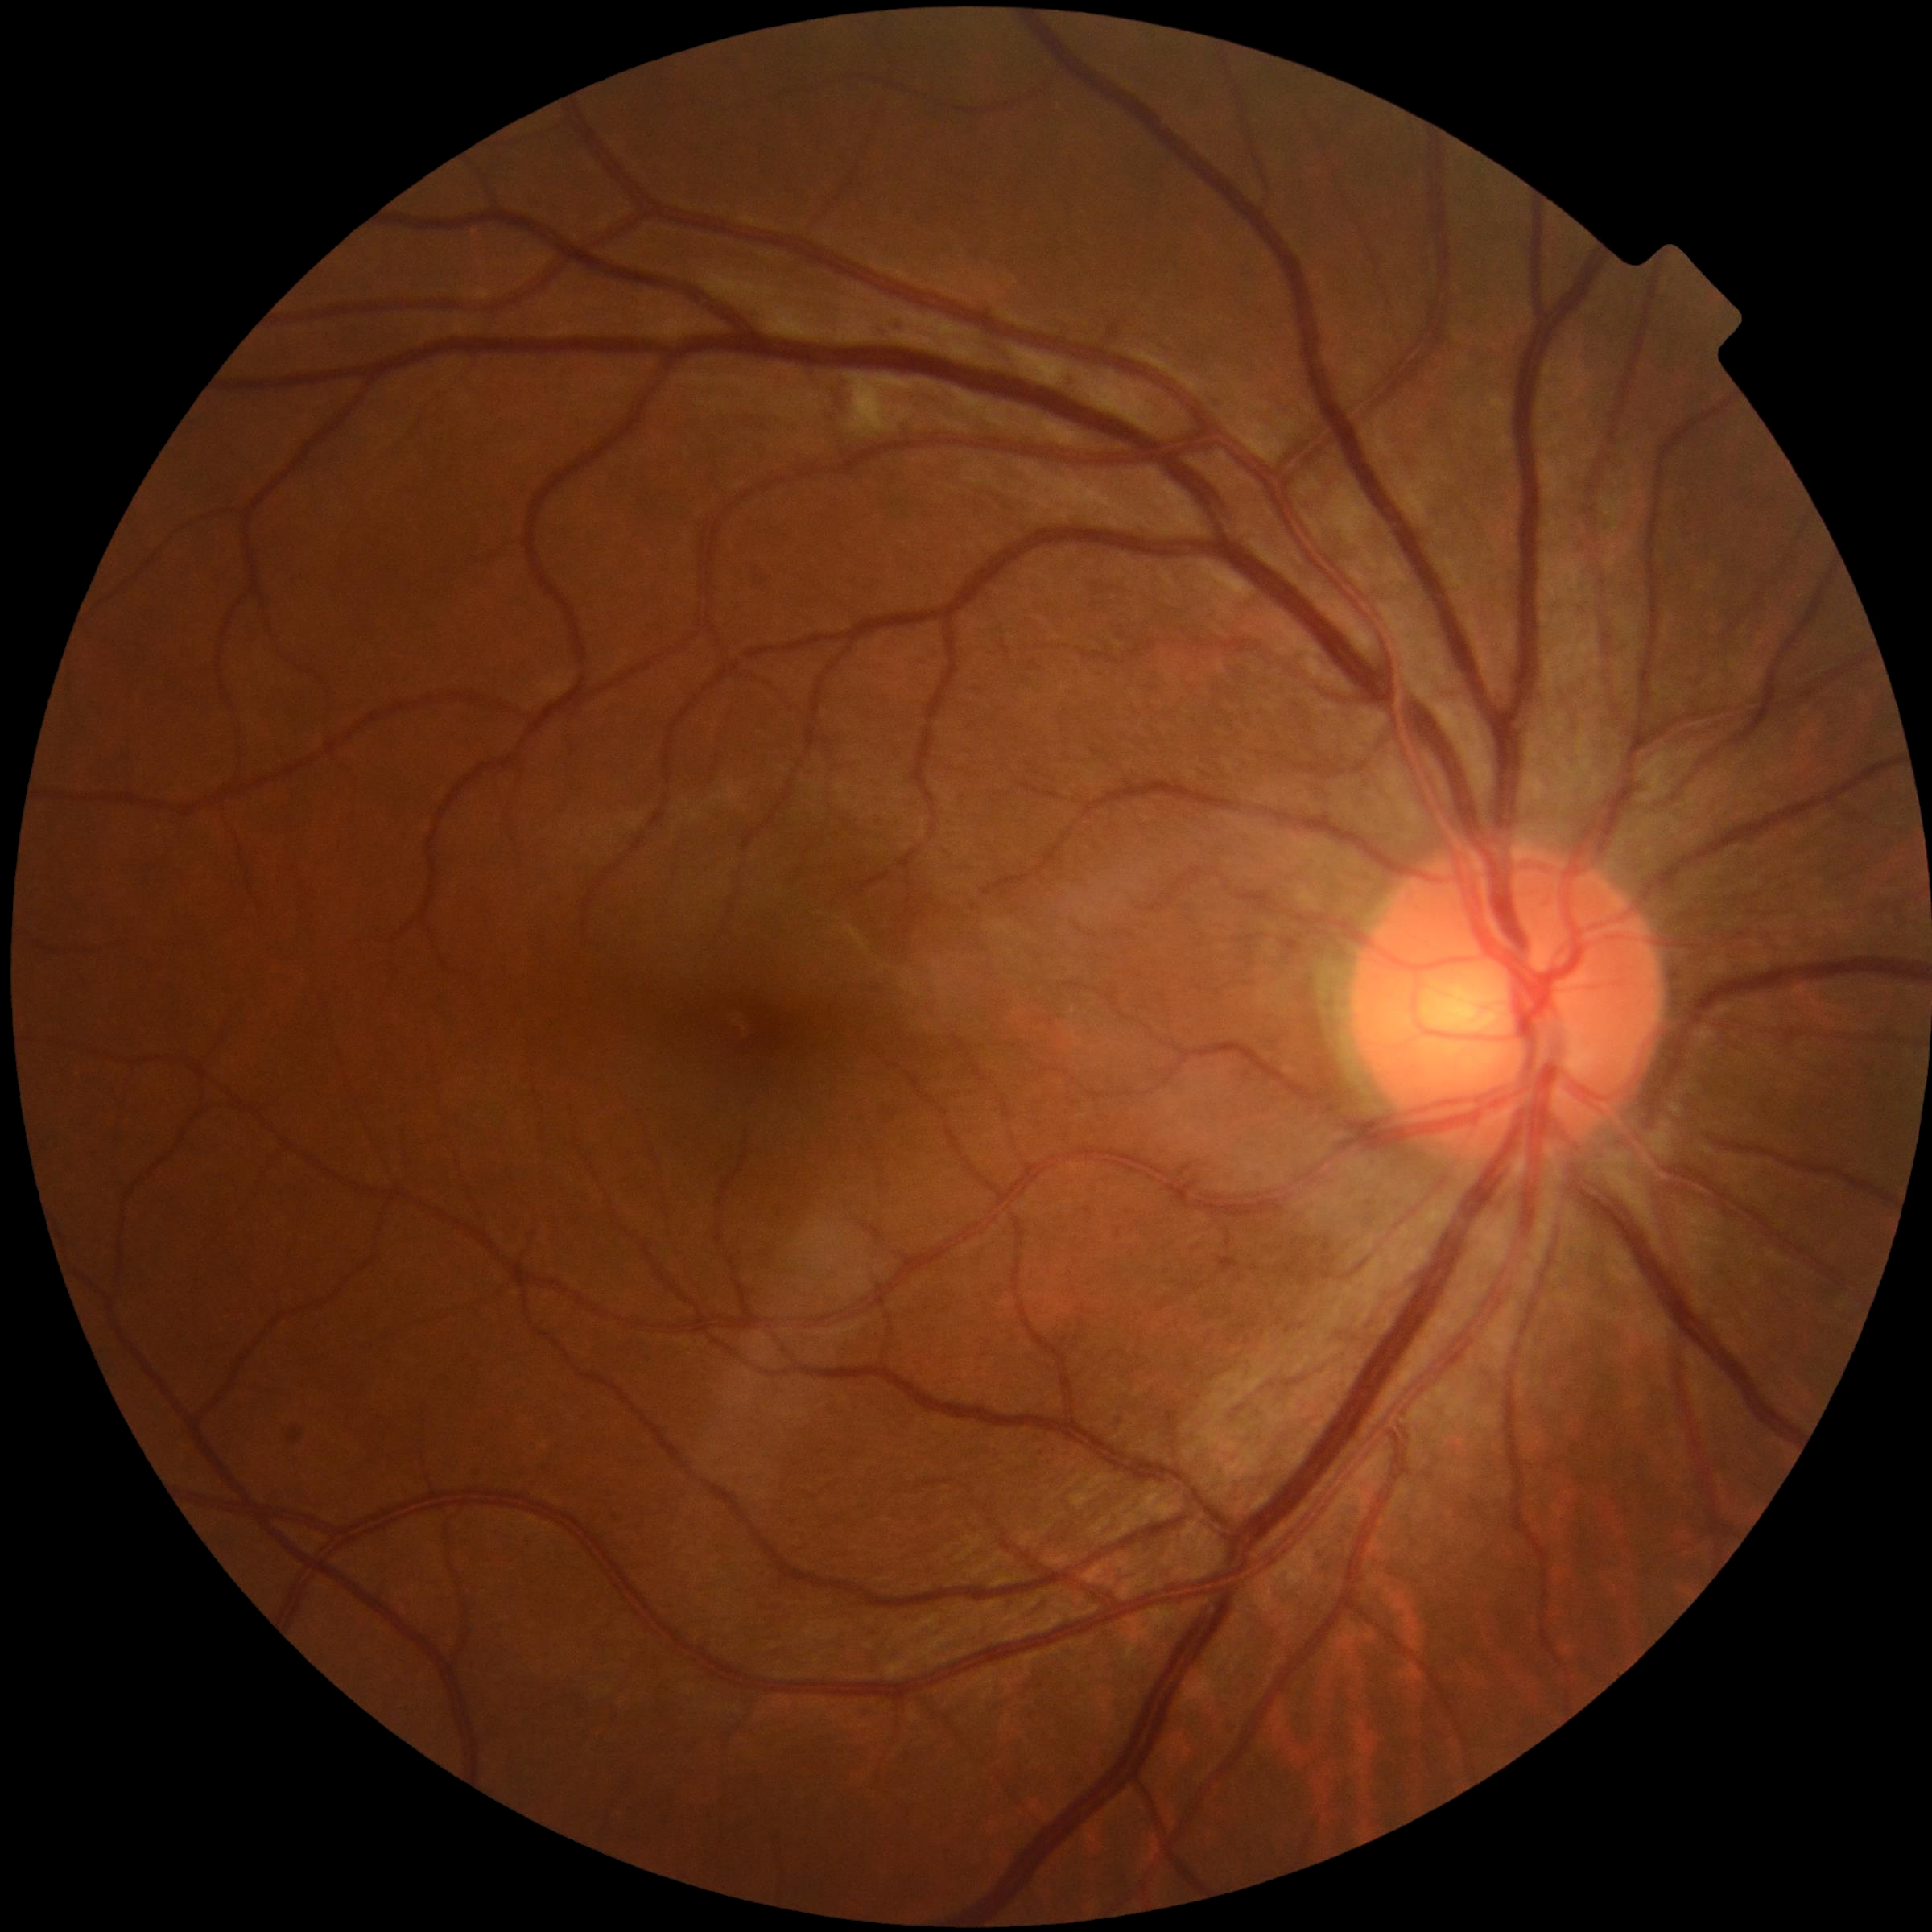

DR grade: 2/4.